640x480px · pediatric retinal photograph (wide-field) · captured with the Clarity RetCam 3 (130° field of view):
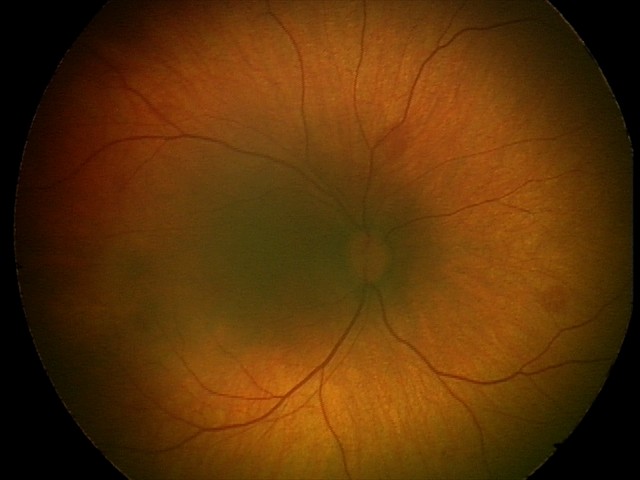
Series diagnosed as retinal hemorrhages.